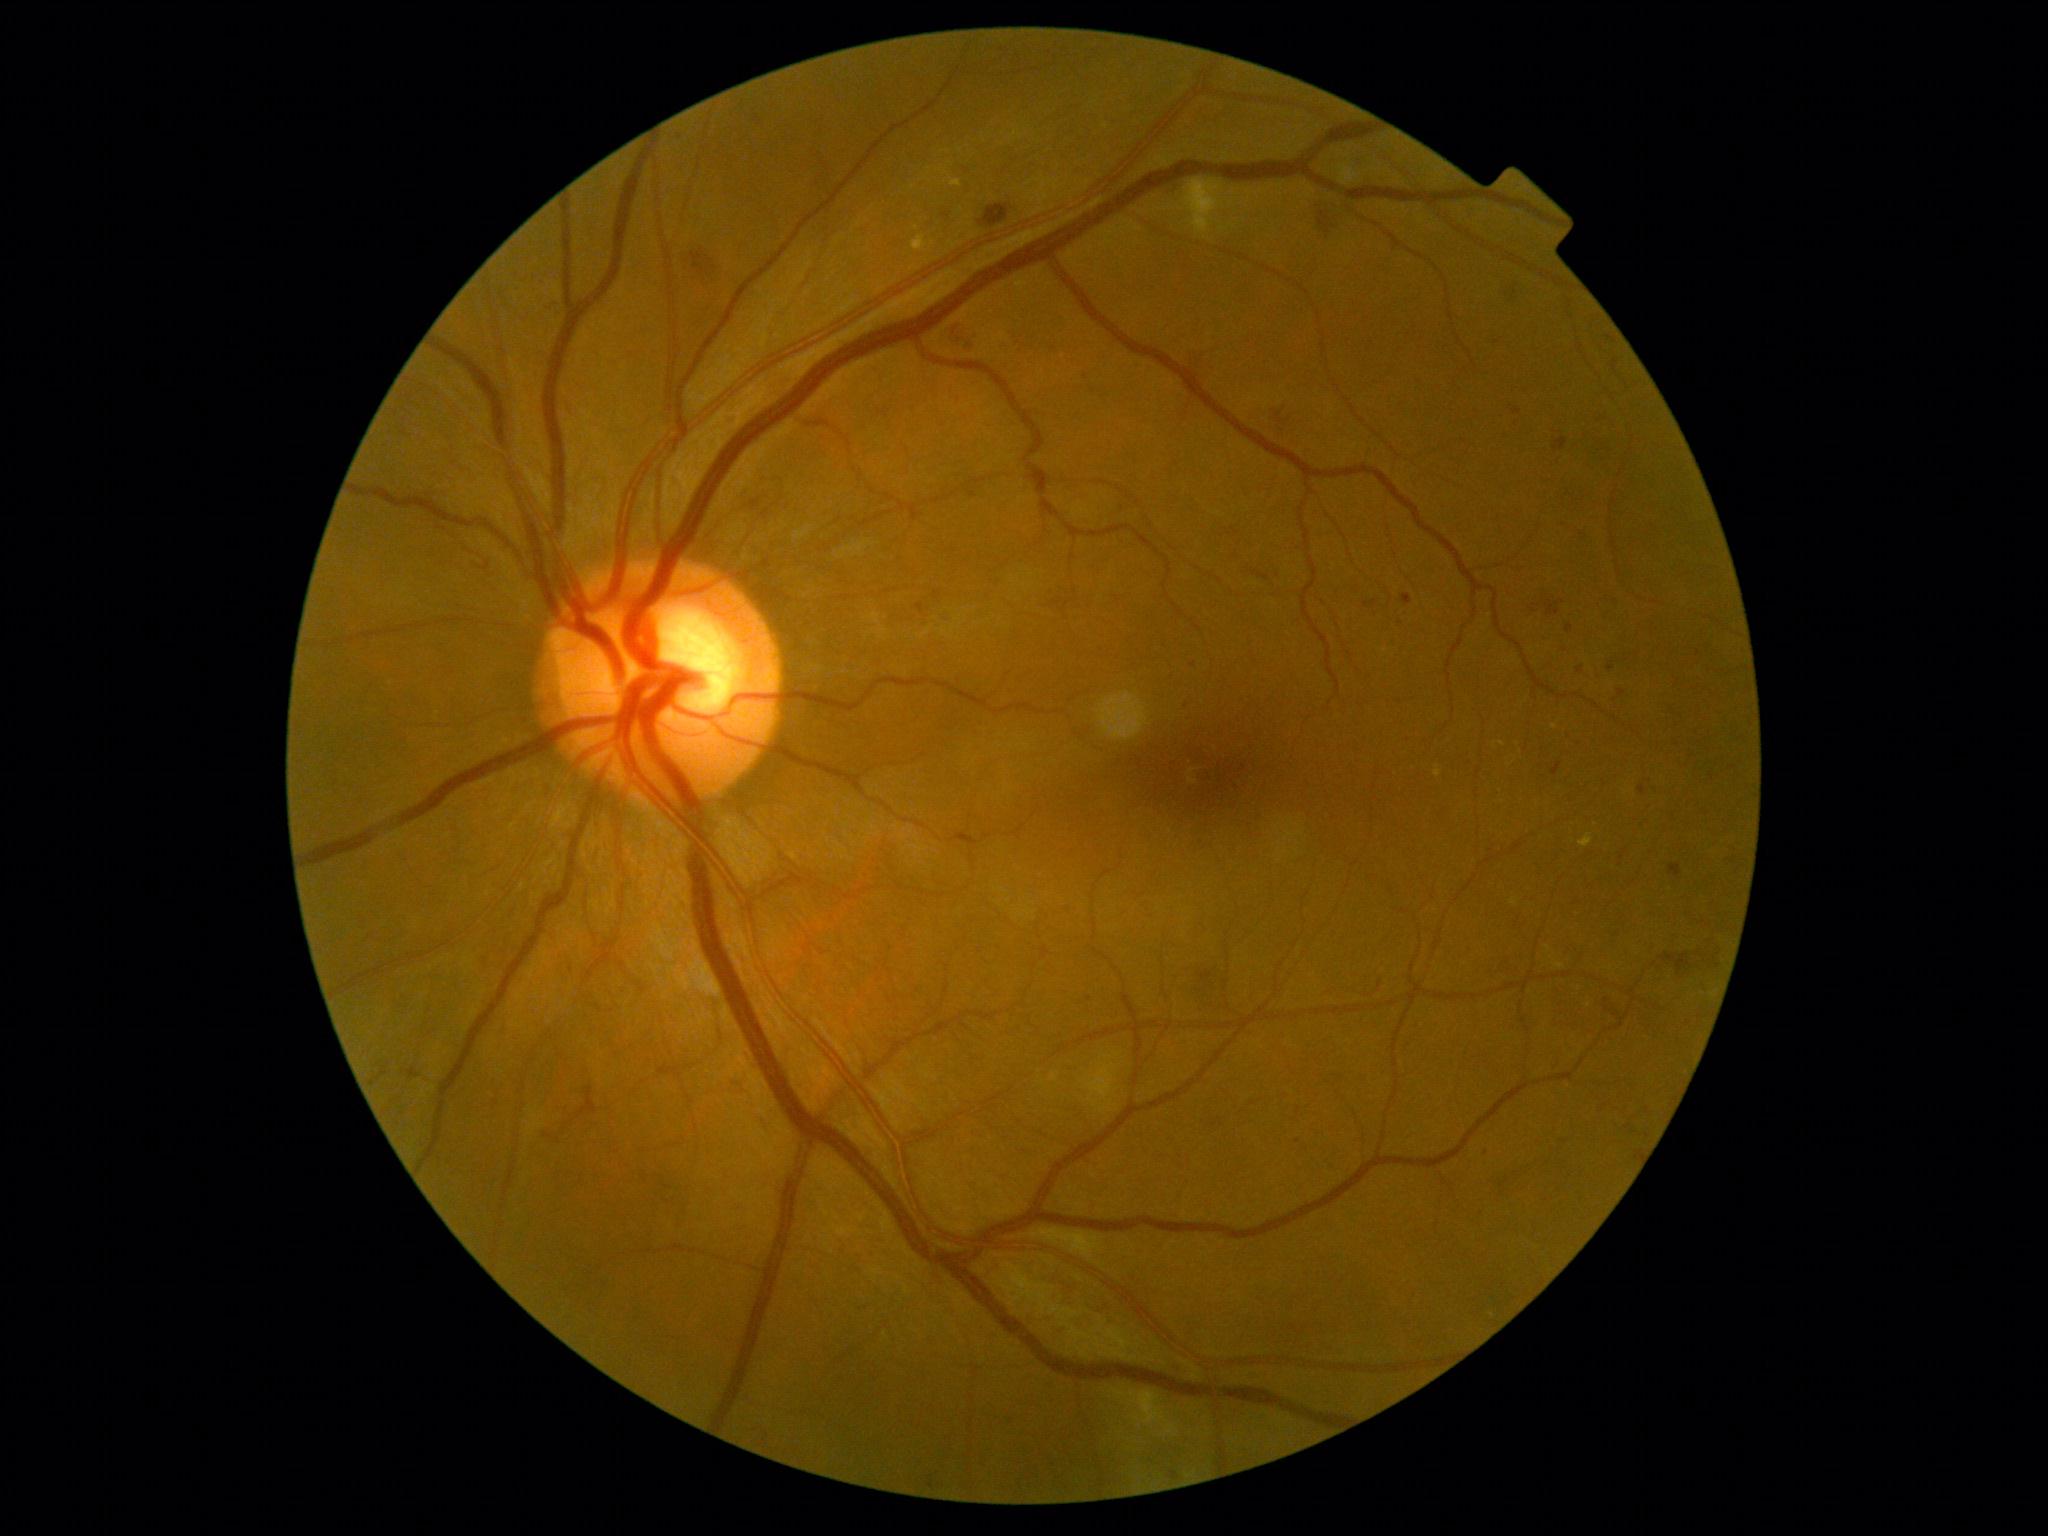

Diabetic retinopathy (DR) is grade 2 (moderate NPDR) — more than just microaneurysms but less than severe NPDR
Selected lesions:
* microaneurysms (MAs) (more not shown): region(1618, 852, 1627, 867) | region(928, 1476, 935, 1489) | region(1576, 667, 1584, 674) | region(1064, 908, 1073, 916) | region(1639, 785, 1646, 795) | region(1005, 1422, 1015, 1428) | region(550, 301, 558, 314) | region(916, 604, 925, 614) | region(1556, 1143, 1566, 1151) | region(1253, 570, 1269, 582)
* Small MAs approximately at x=1611, y=667 | x=1609, y=618 | x=1648, y=1136 | x=1629, y=1126